848x848: 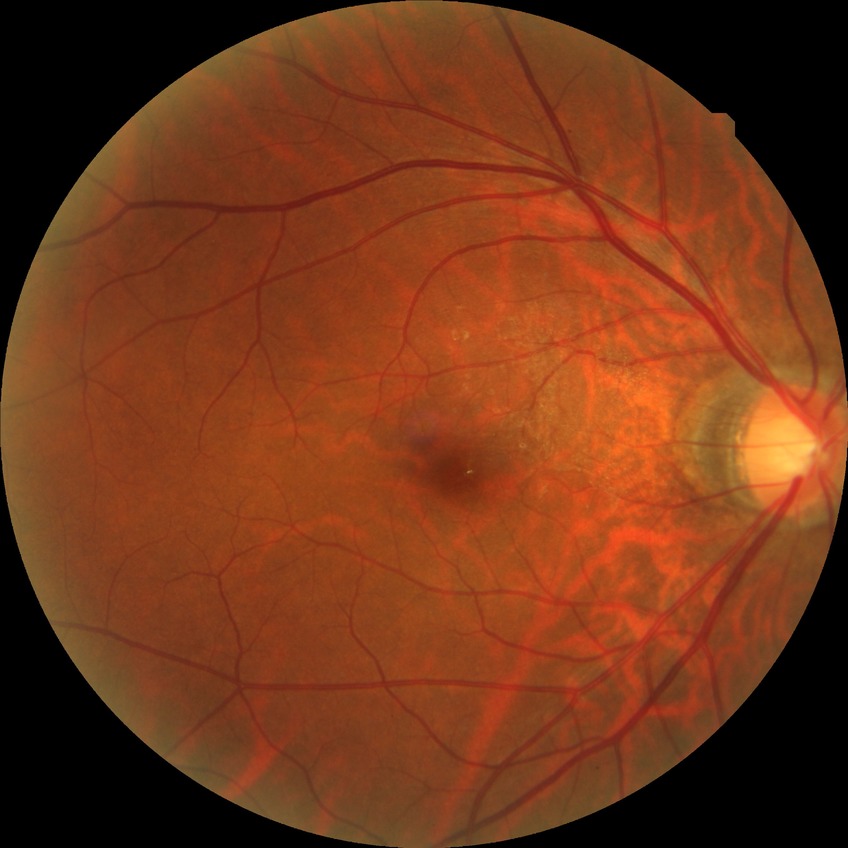 modified Davis classification@simple diabetic retinopathy.